45-degree field of view:
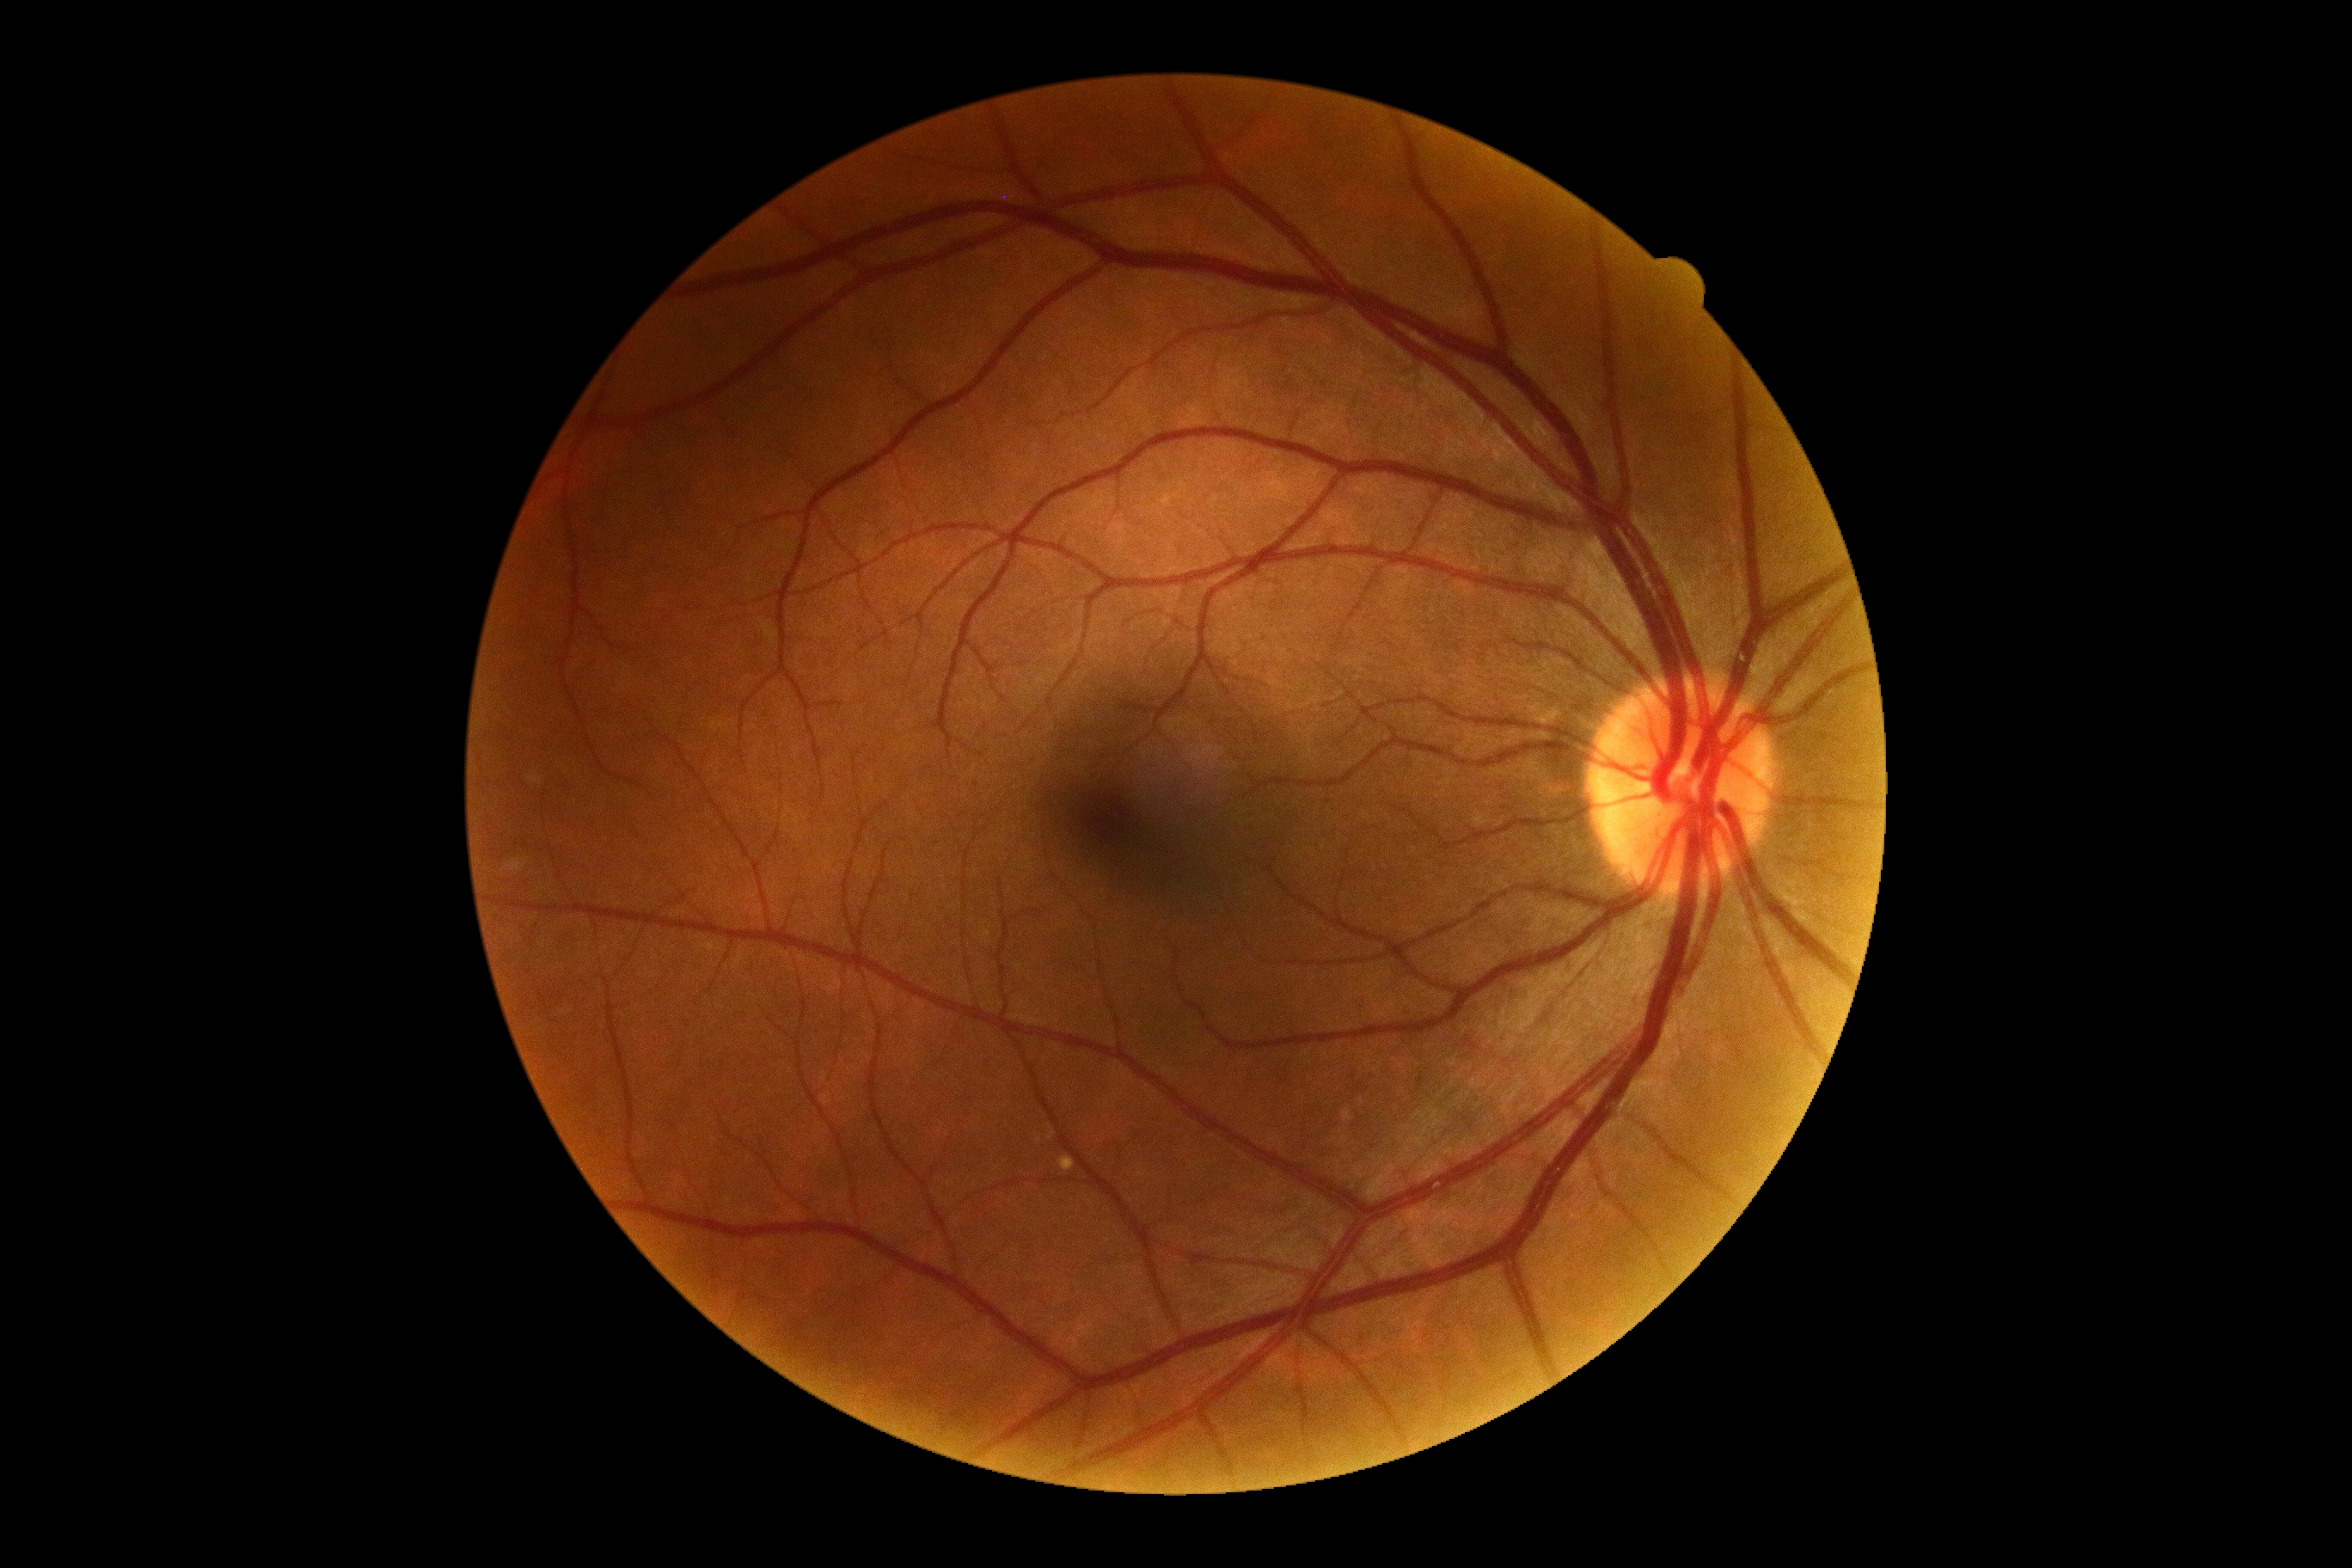 DR: 0/4. No diabetic retinal disease findings.